DR severity per modified Davis staging, fundus photo, no pharmacologic dilation, 45 degree fundus photograph
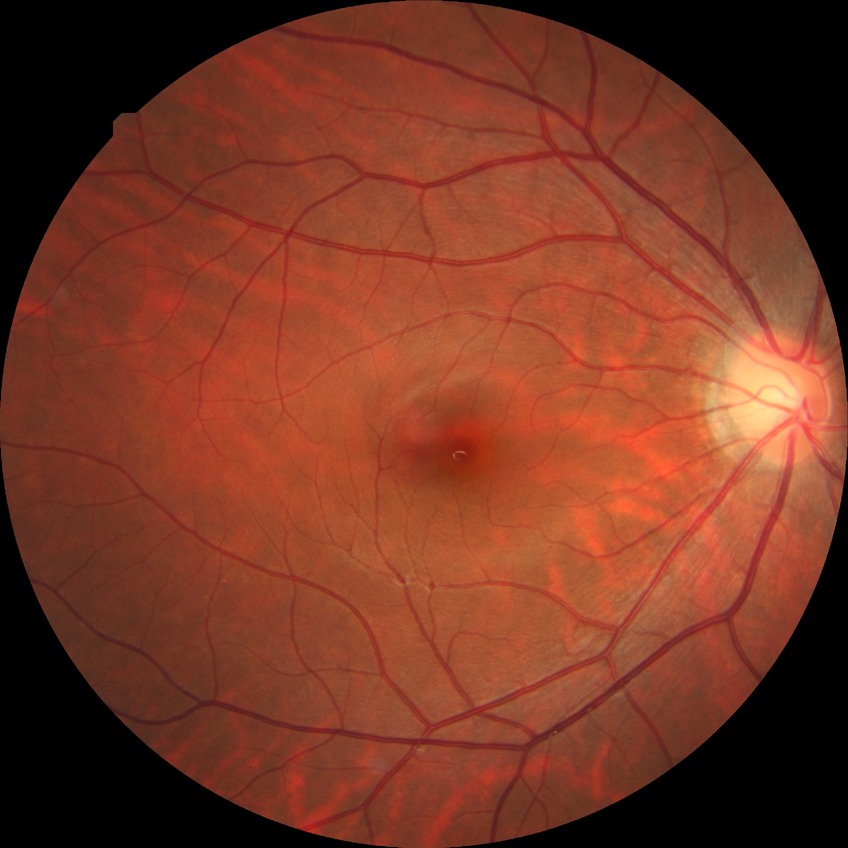 Diabetic retinopathy (DR): NDR (no diabetic retinopathy).